Fundus photo:
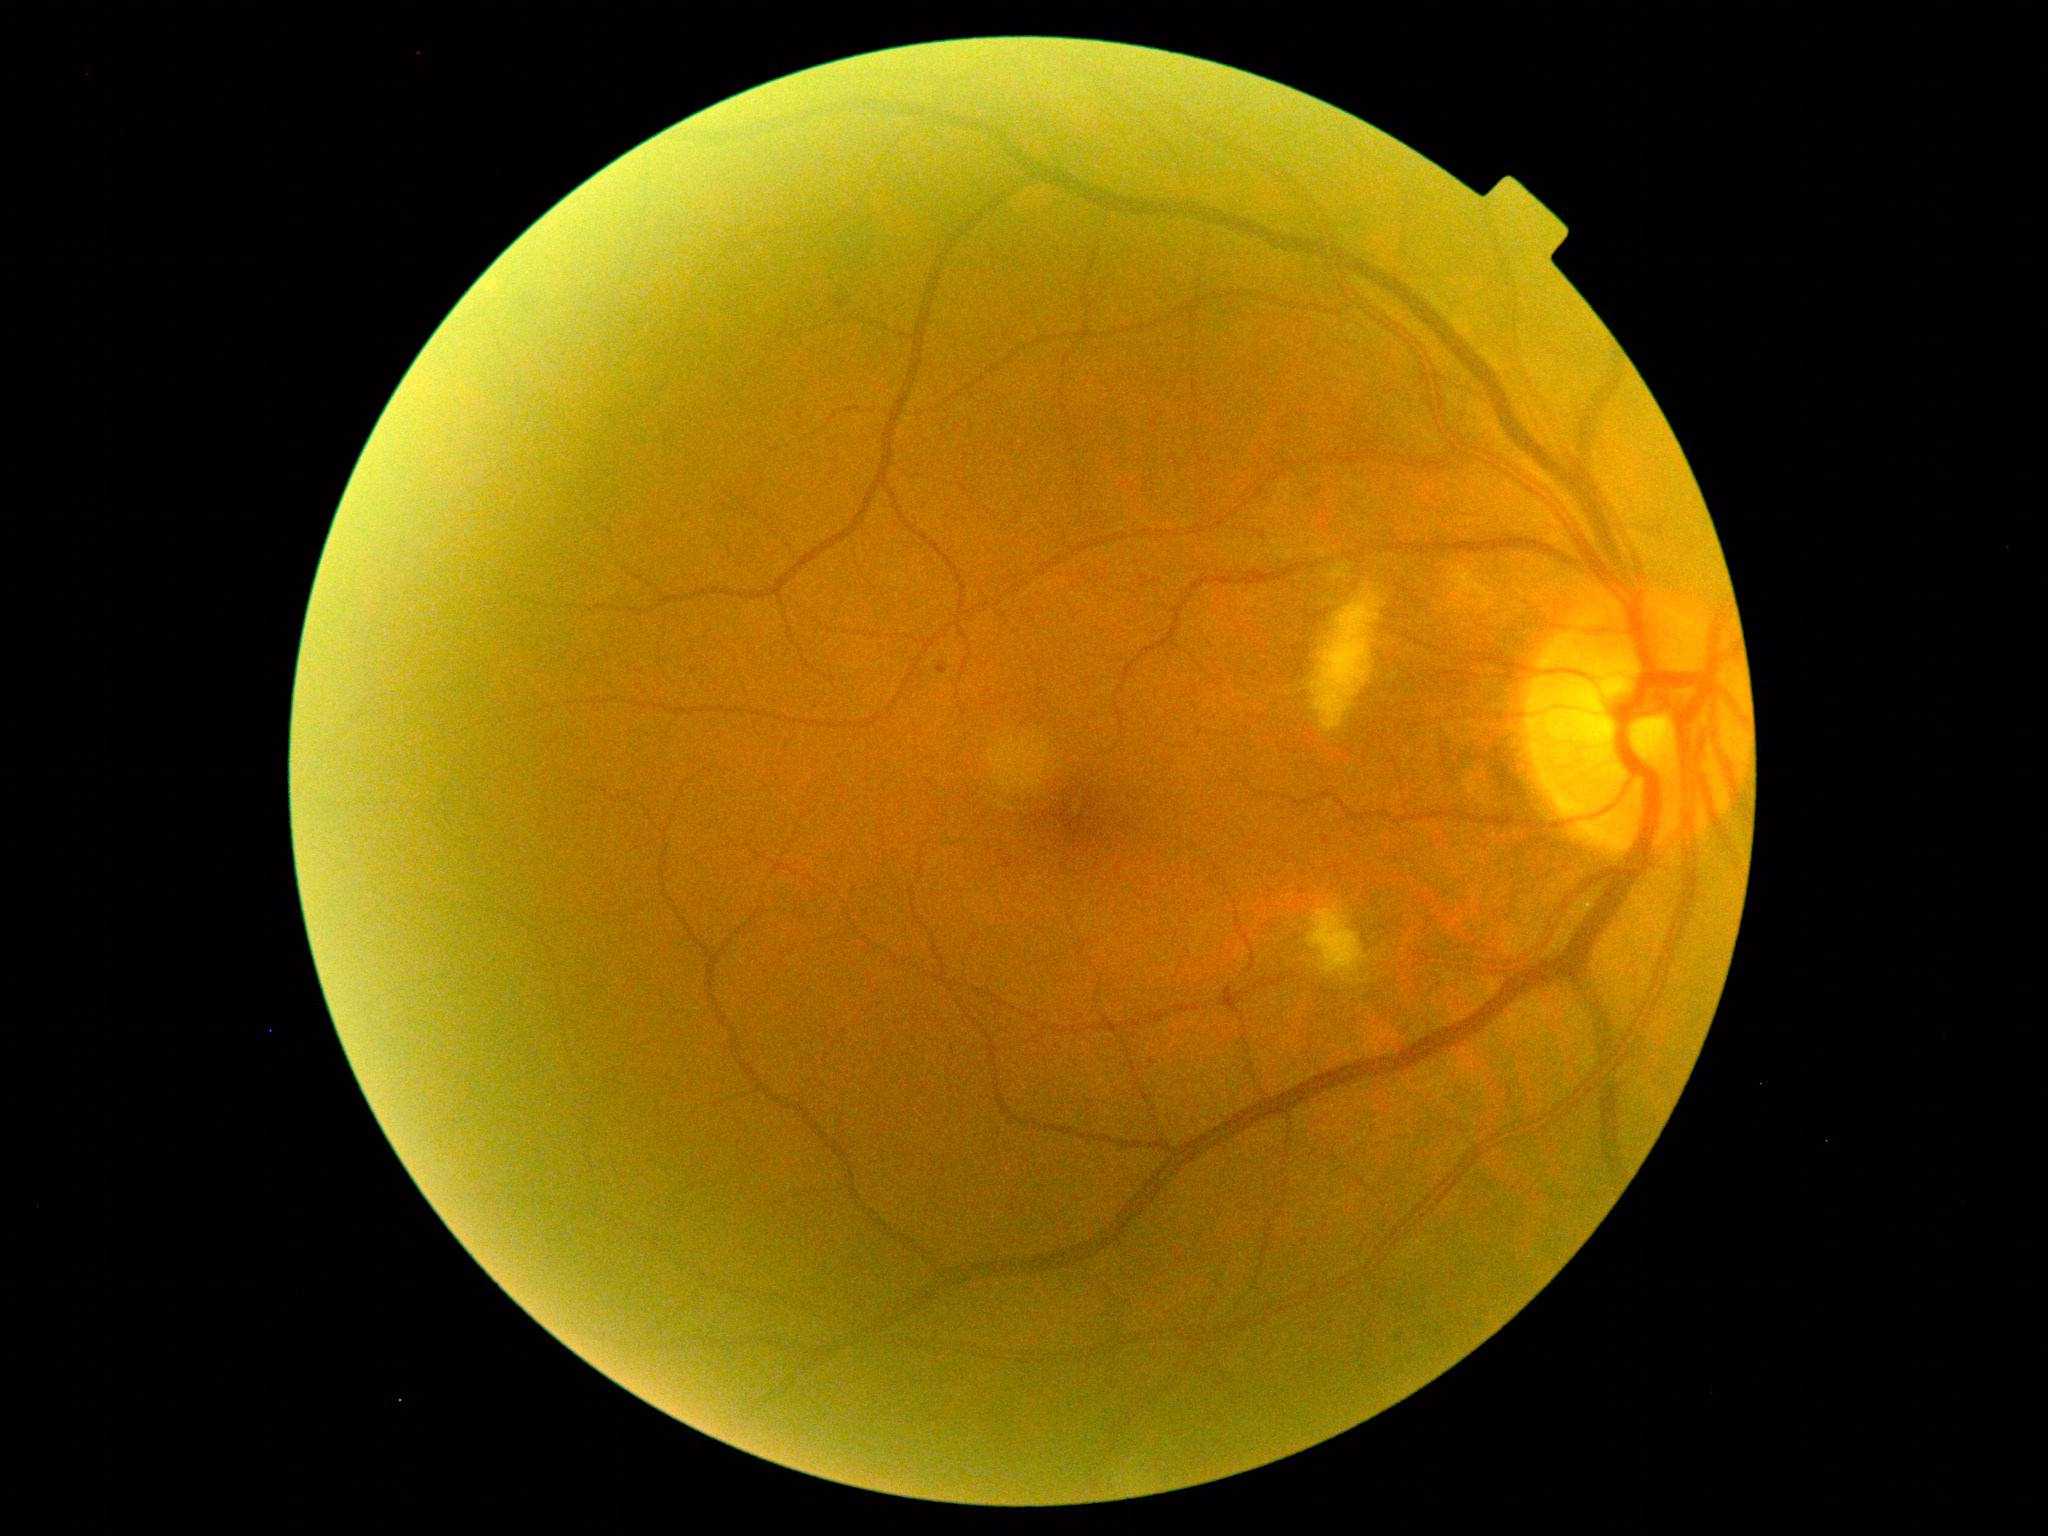

dr_grade: moderate NPDR (grade 2)